Pediatric retinal photograph (wide-field):
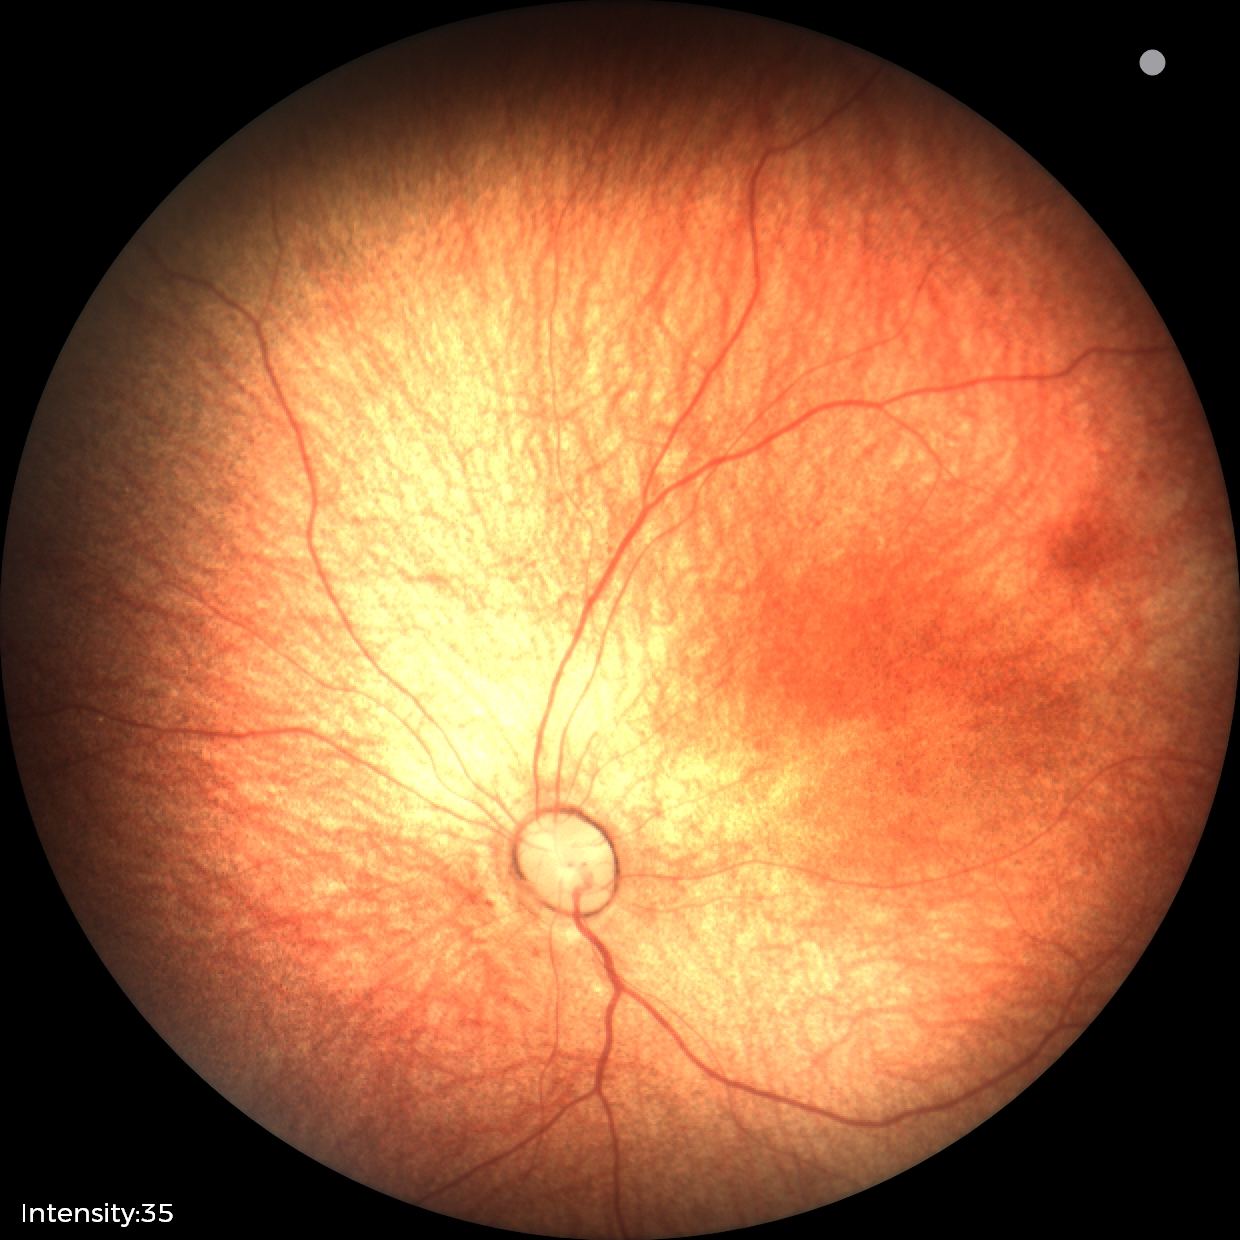
Screening diagnosis = no abnormalities